Graded on the modified Davis scale:
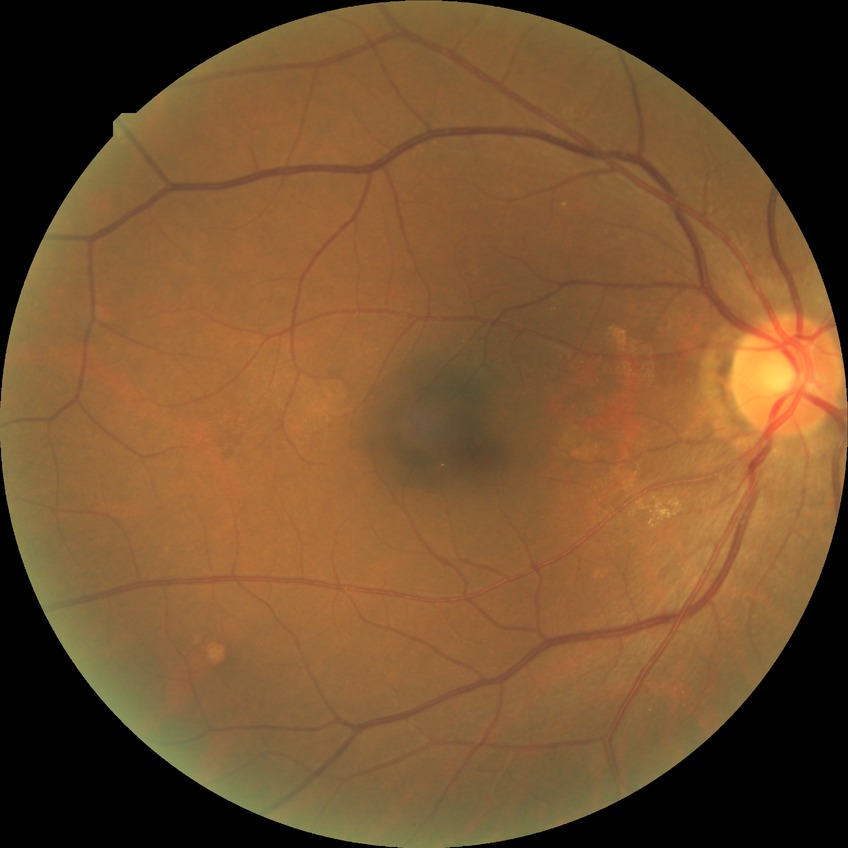 davis_grade: no diabetic retinopathy